640x480; pediatric wide-field fundus photograph: 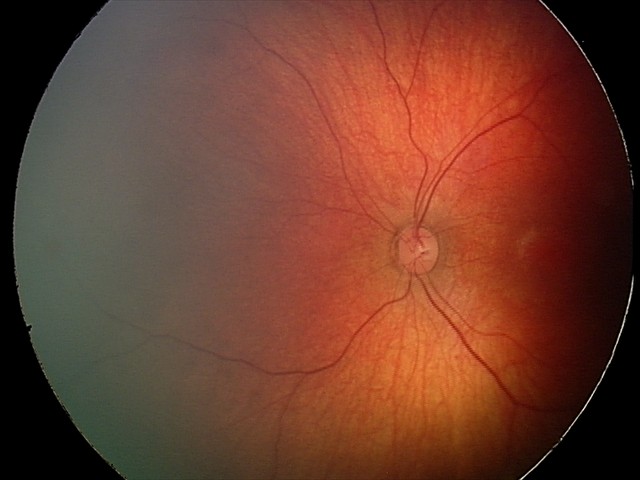

Screening diagnosis: retinal hemorrhages.